NIDEK AFC-230 fundus camera: 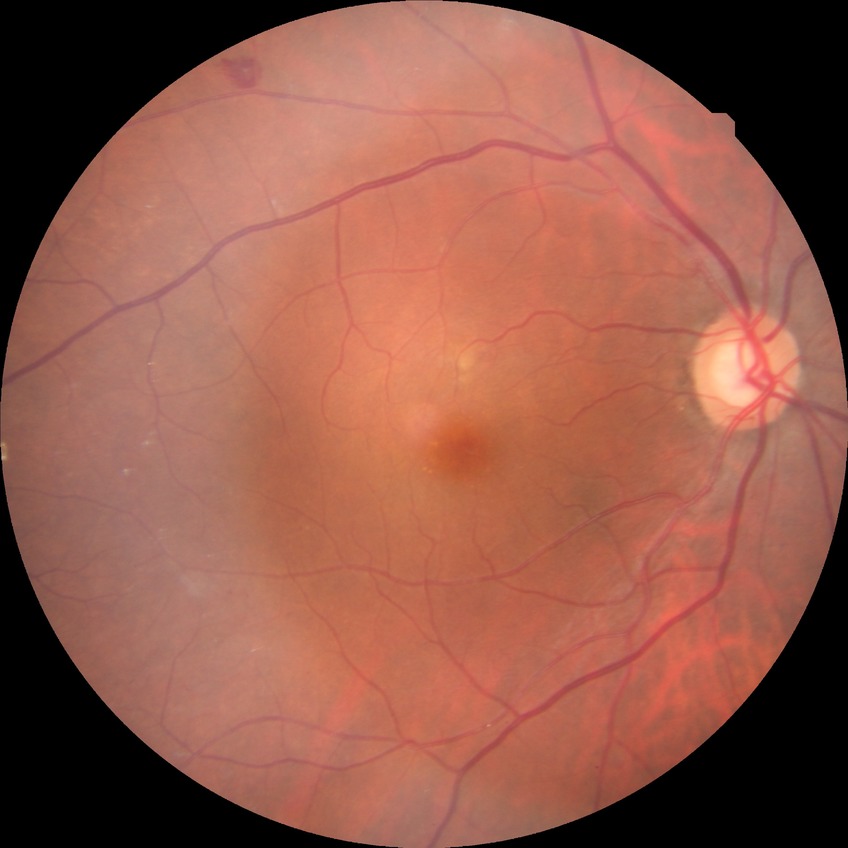

Diabetic retinopathy (DR) is simple diabetic retinopathy (SDR).